Dilated-pupil acquisition — 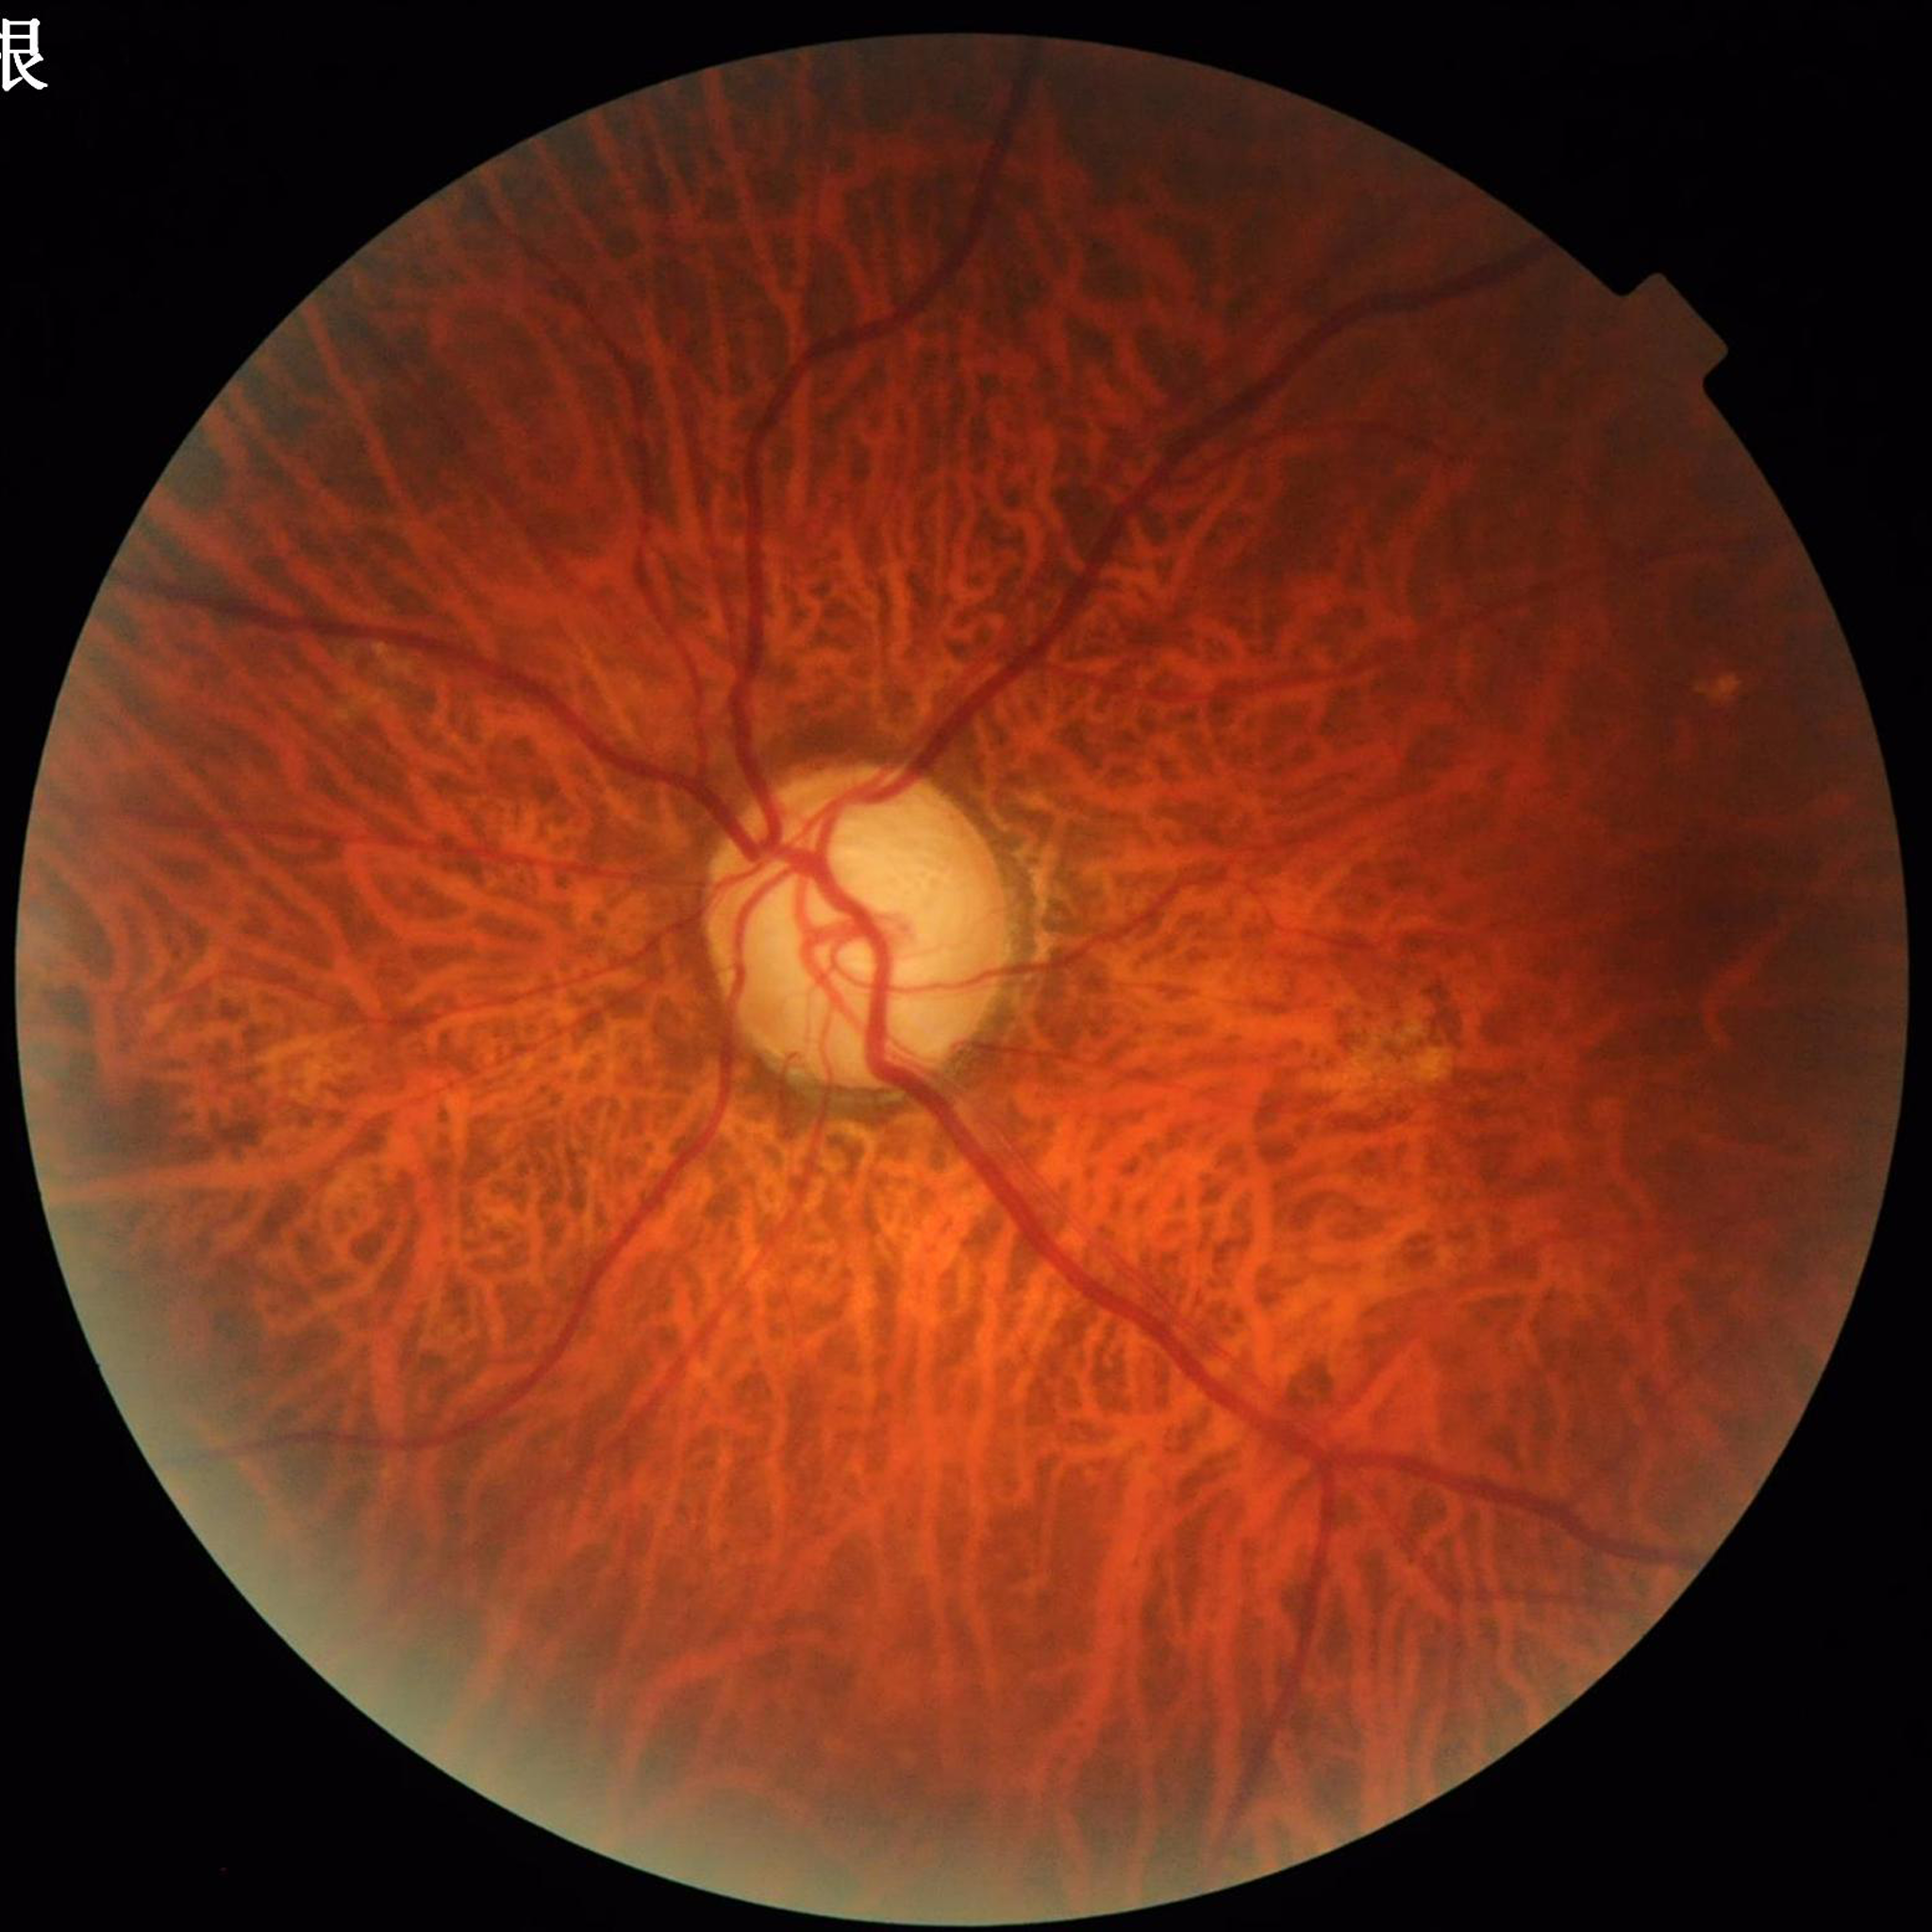
The patient was diagnosed with glaucoma.